Wide-field fundus photograph from neonatal ROP screening:
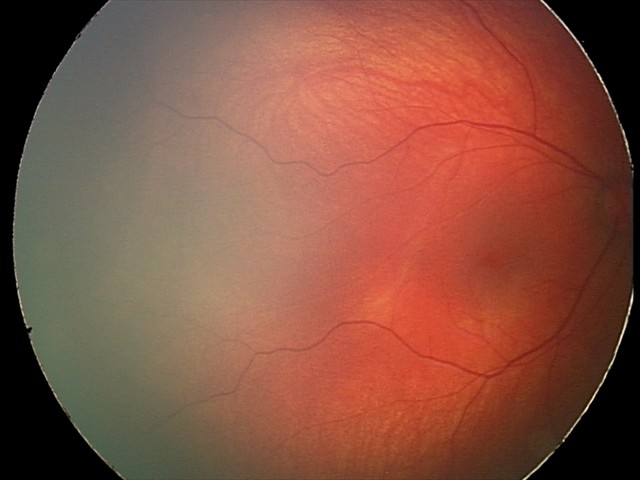

Examination diagnosed as retinal hemorrhages.